Modified Davis grading
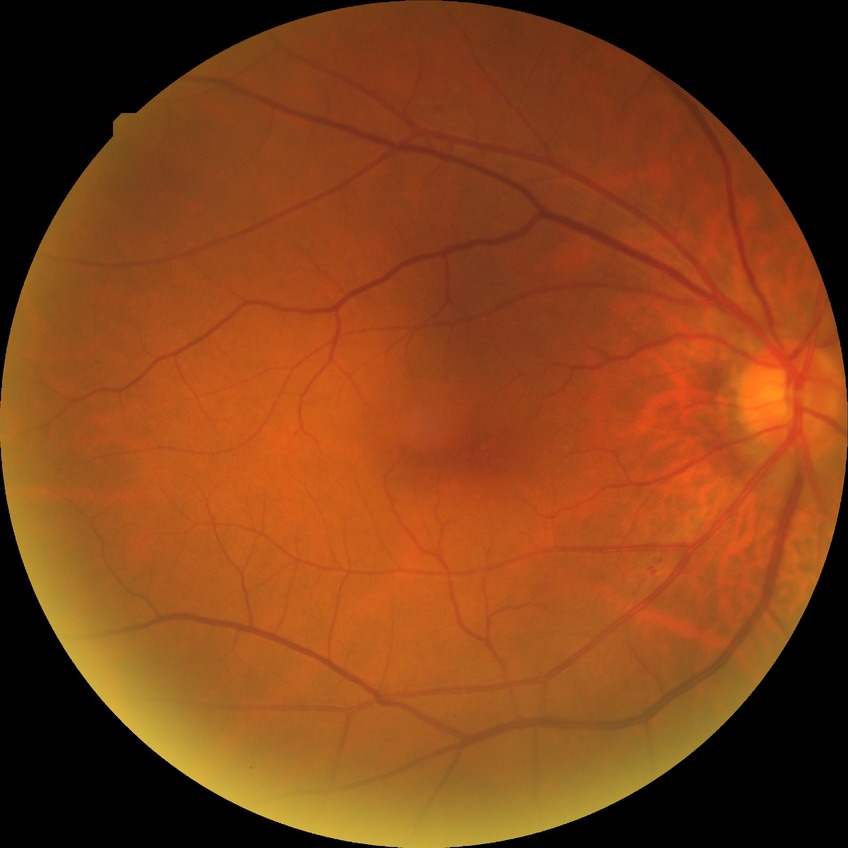
Diabetic retinopathy stage: no diabetic retinopathy.